Image size 1240x1240 · Phoenix ICON wide-field infant fundus image.
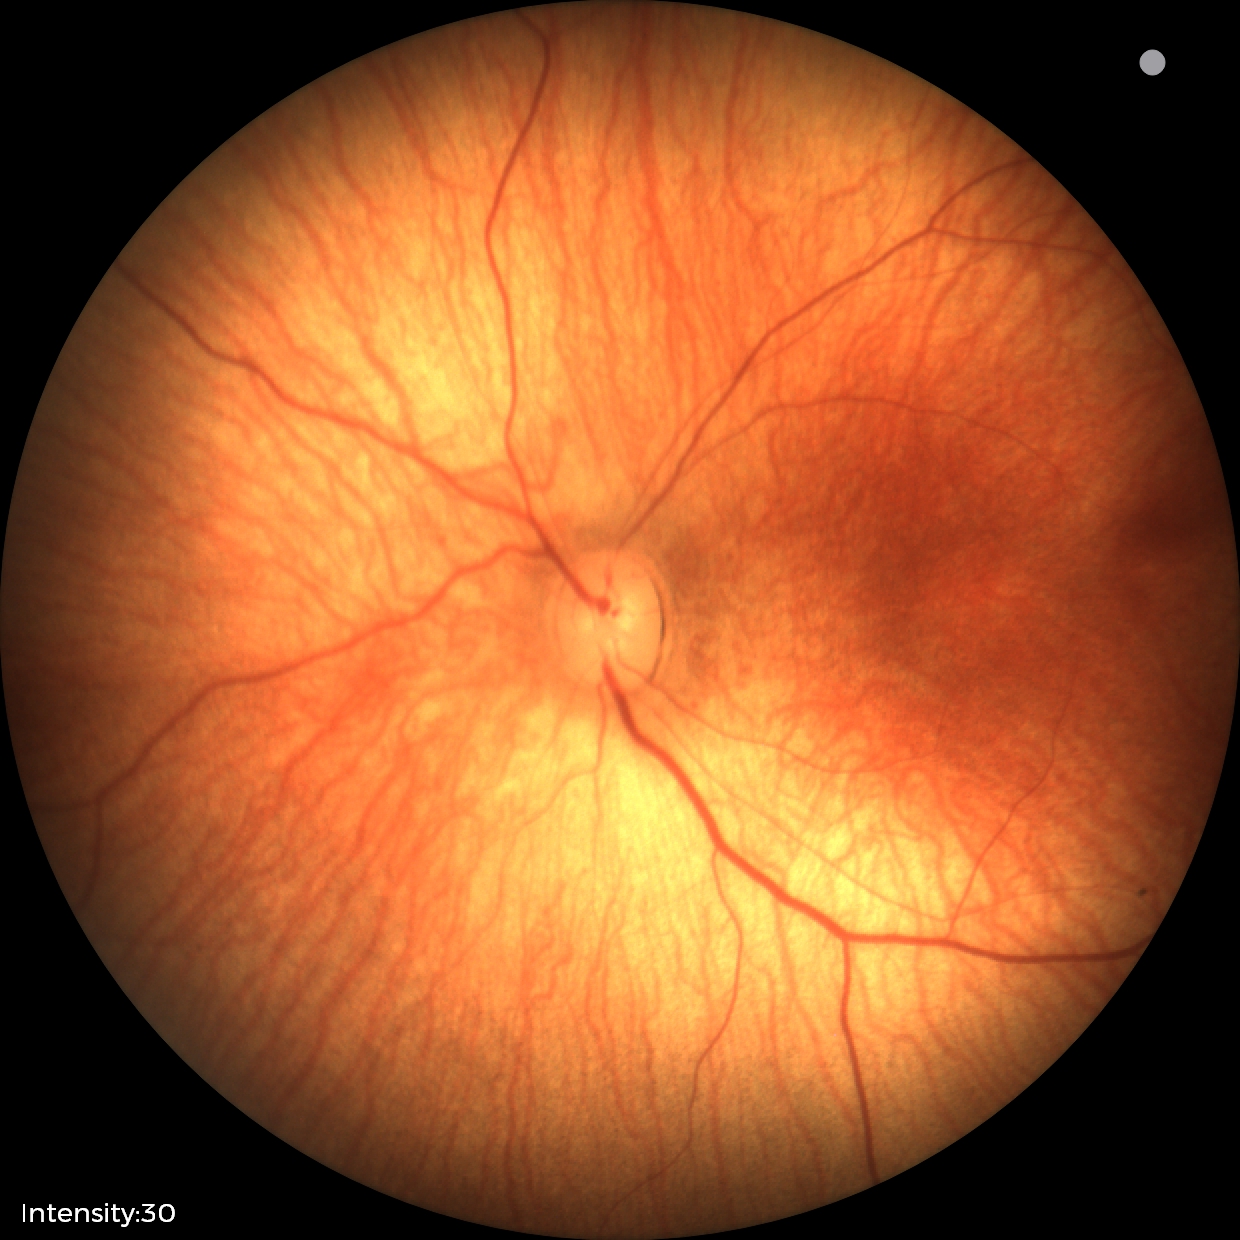

Normal screening examination.